Optic disc photograph, camera: Topcon TRC.
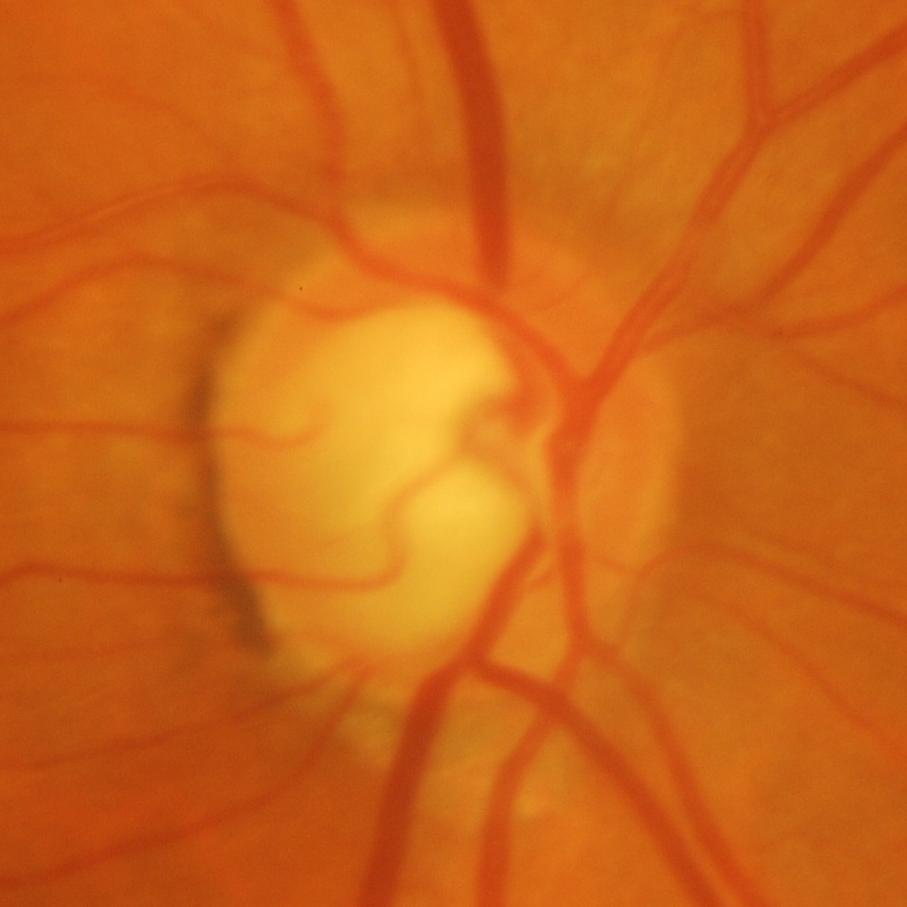 Glaucomatous optic neuropathy is present. Glaucoma diagnosis = glaucomatous damage to the optic nerve.